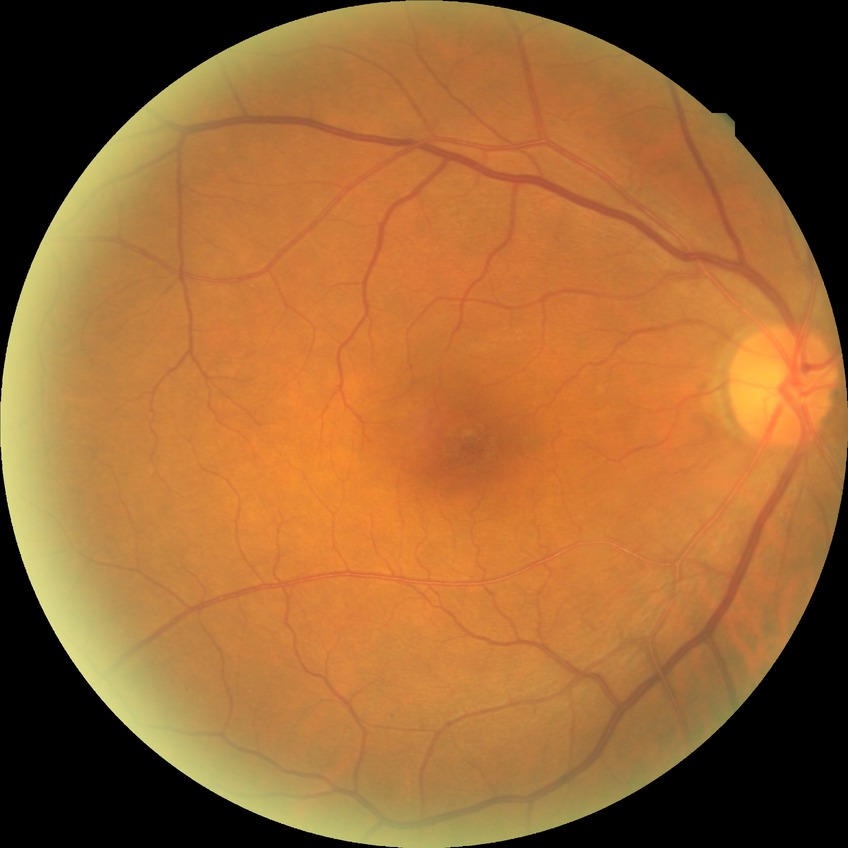

Diabetic retinopathy (DR) is NDR (no diabetic retinopathy).